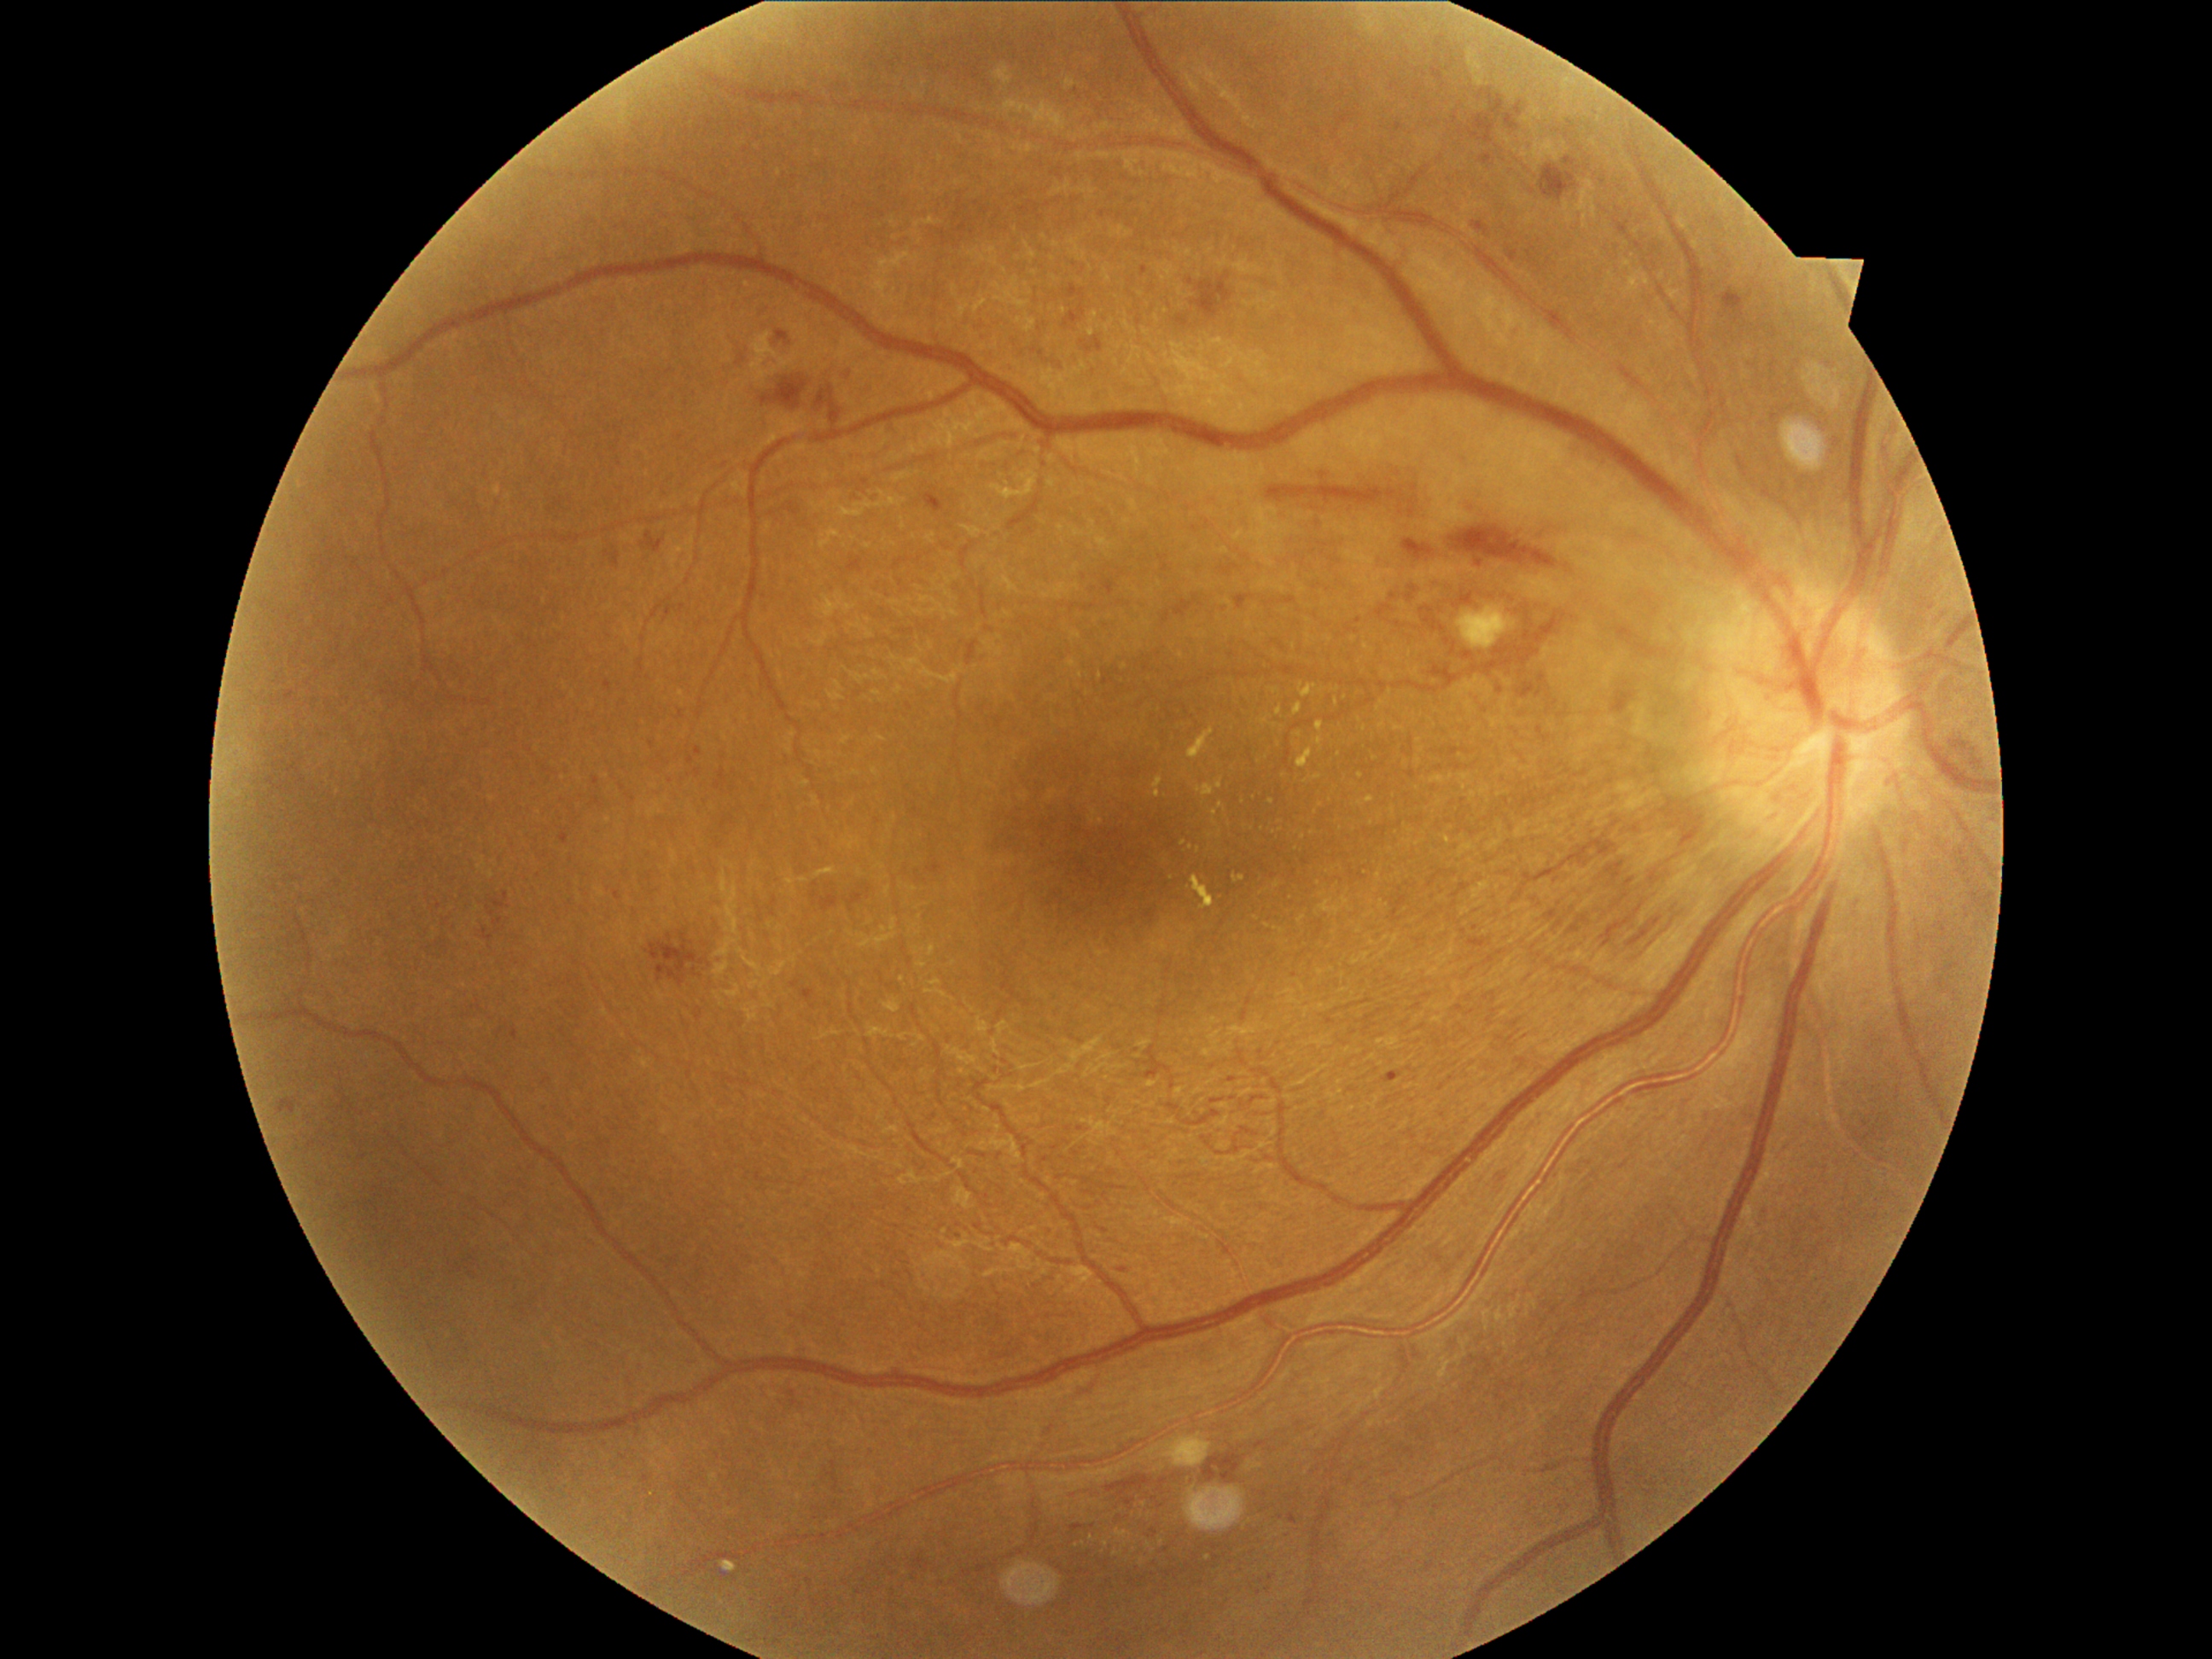

Diabetic retinopathy (DR): grade 4.